Color fundus photograph.
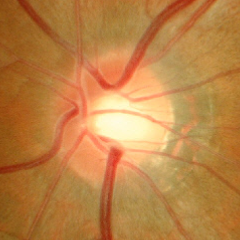 Impression: no glaucomatous changes.